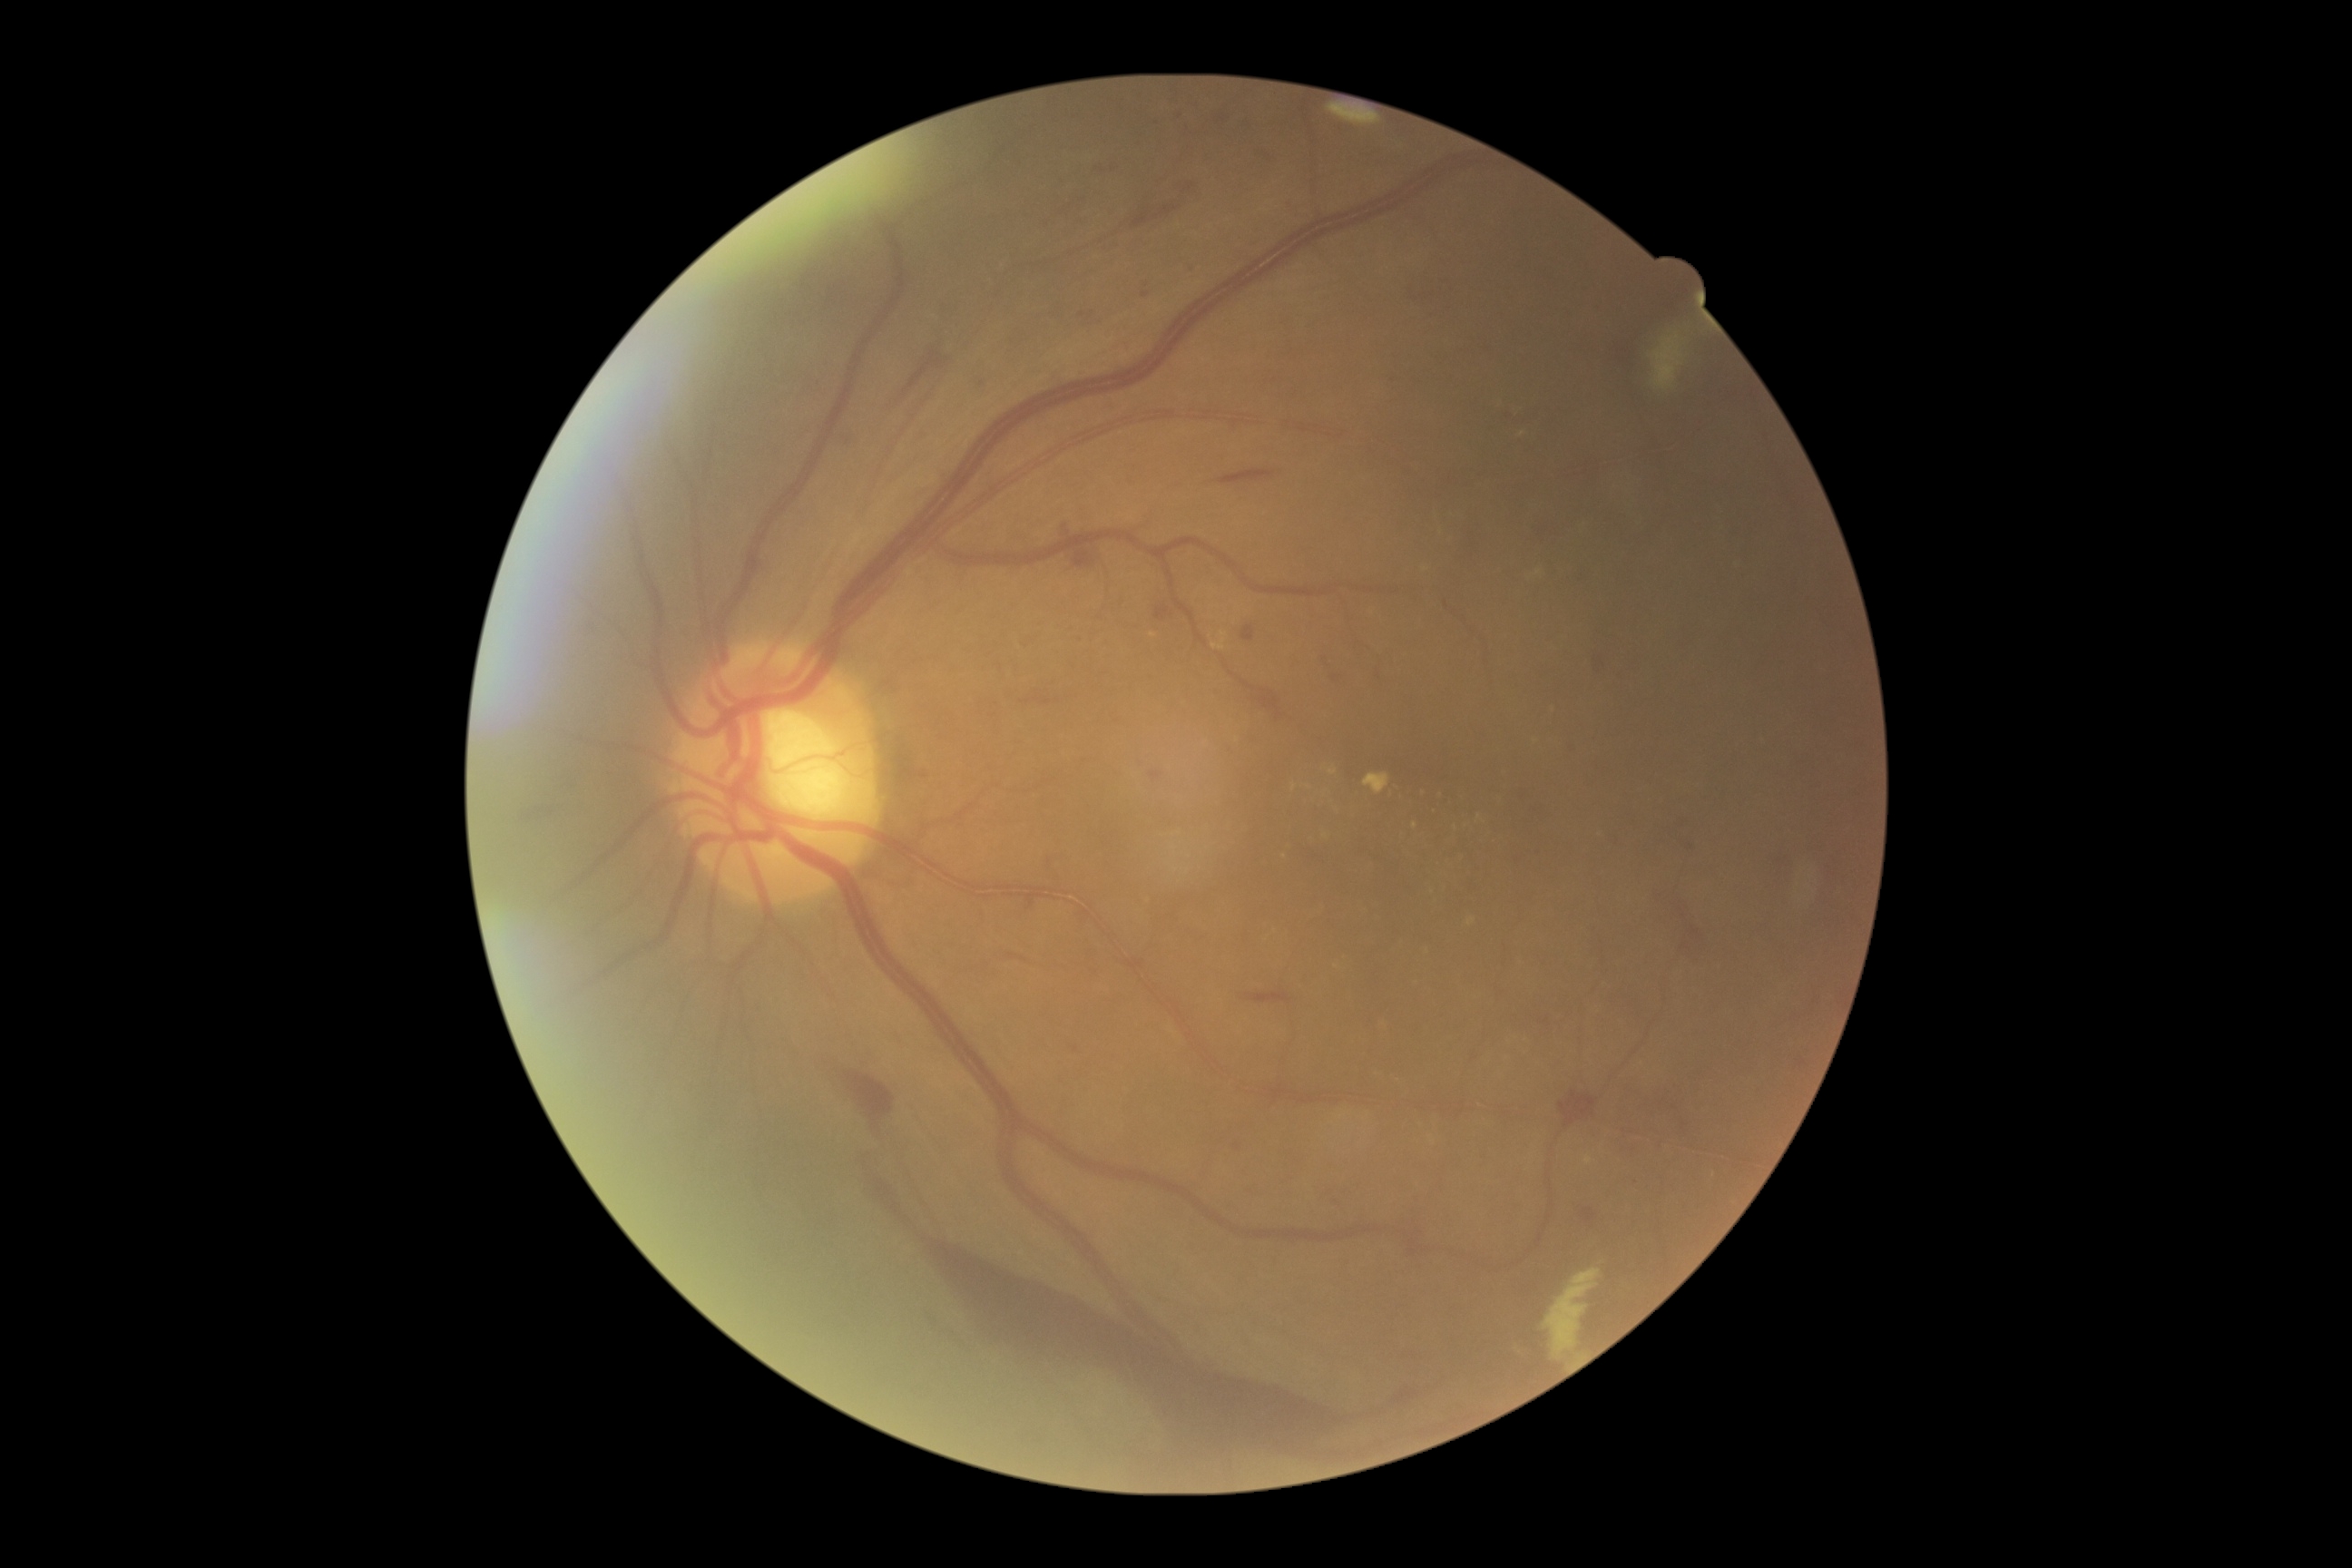

DR grade is 4 — neovascularization and/or vitreous/pre-retinal hemorrhage. The retinopathy is classified as proliferative diabetic retinopathy.